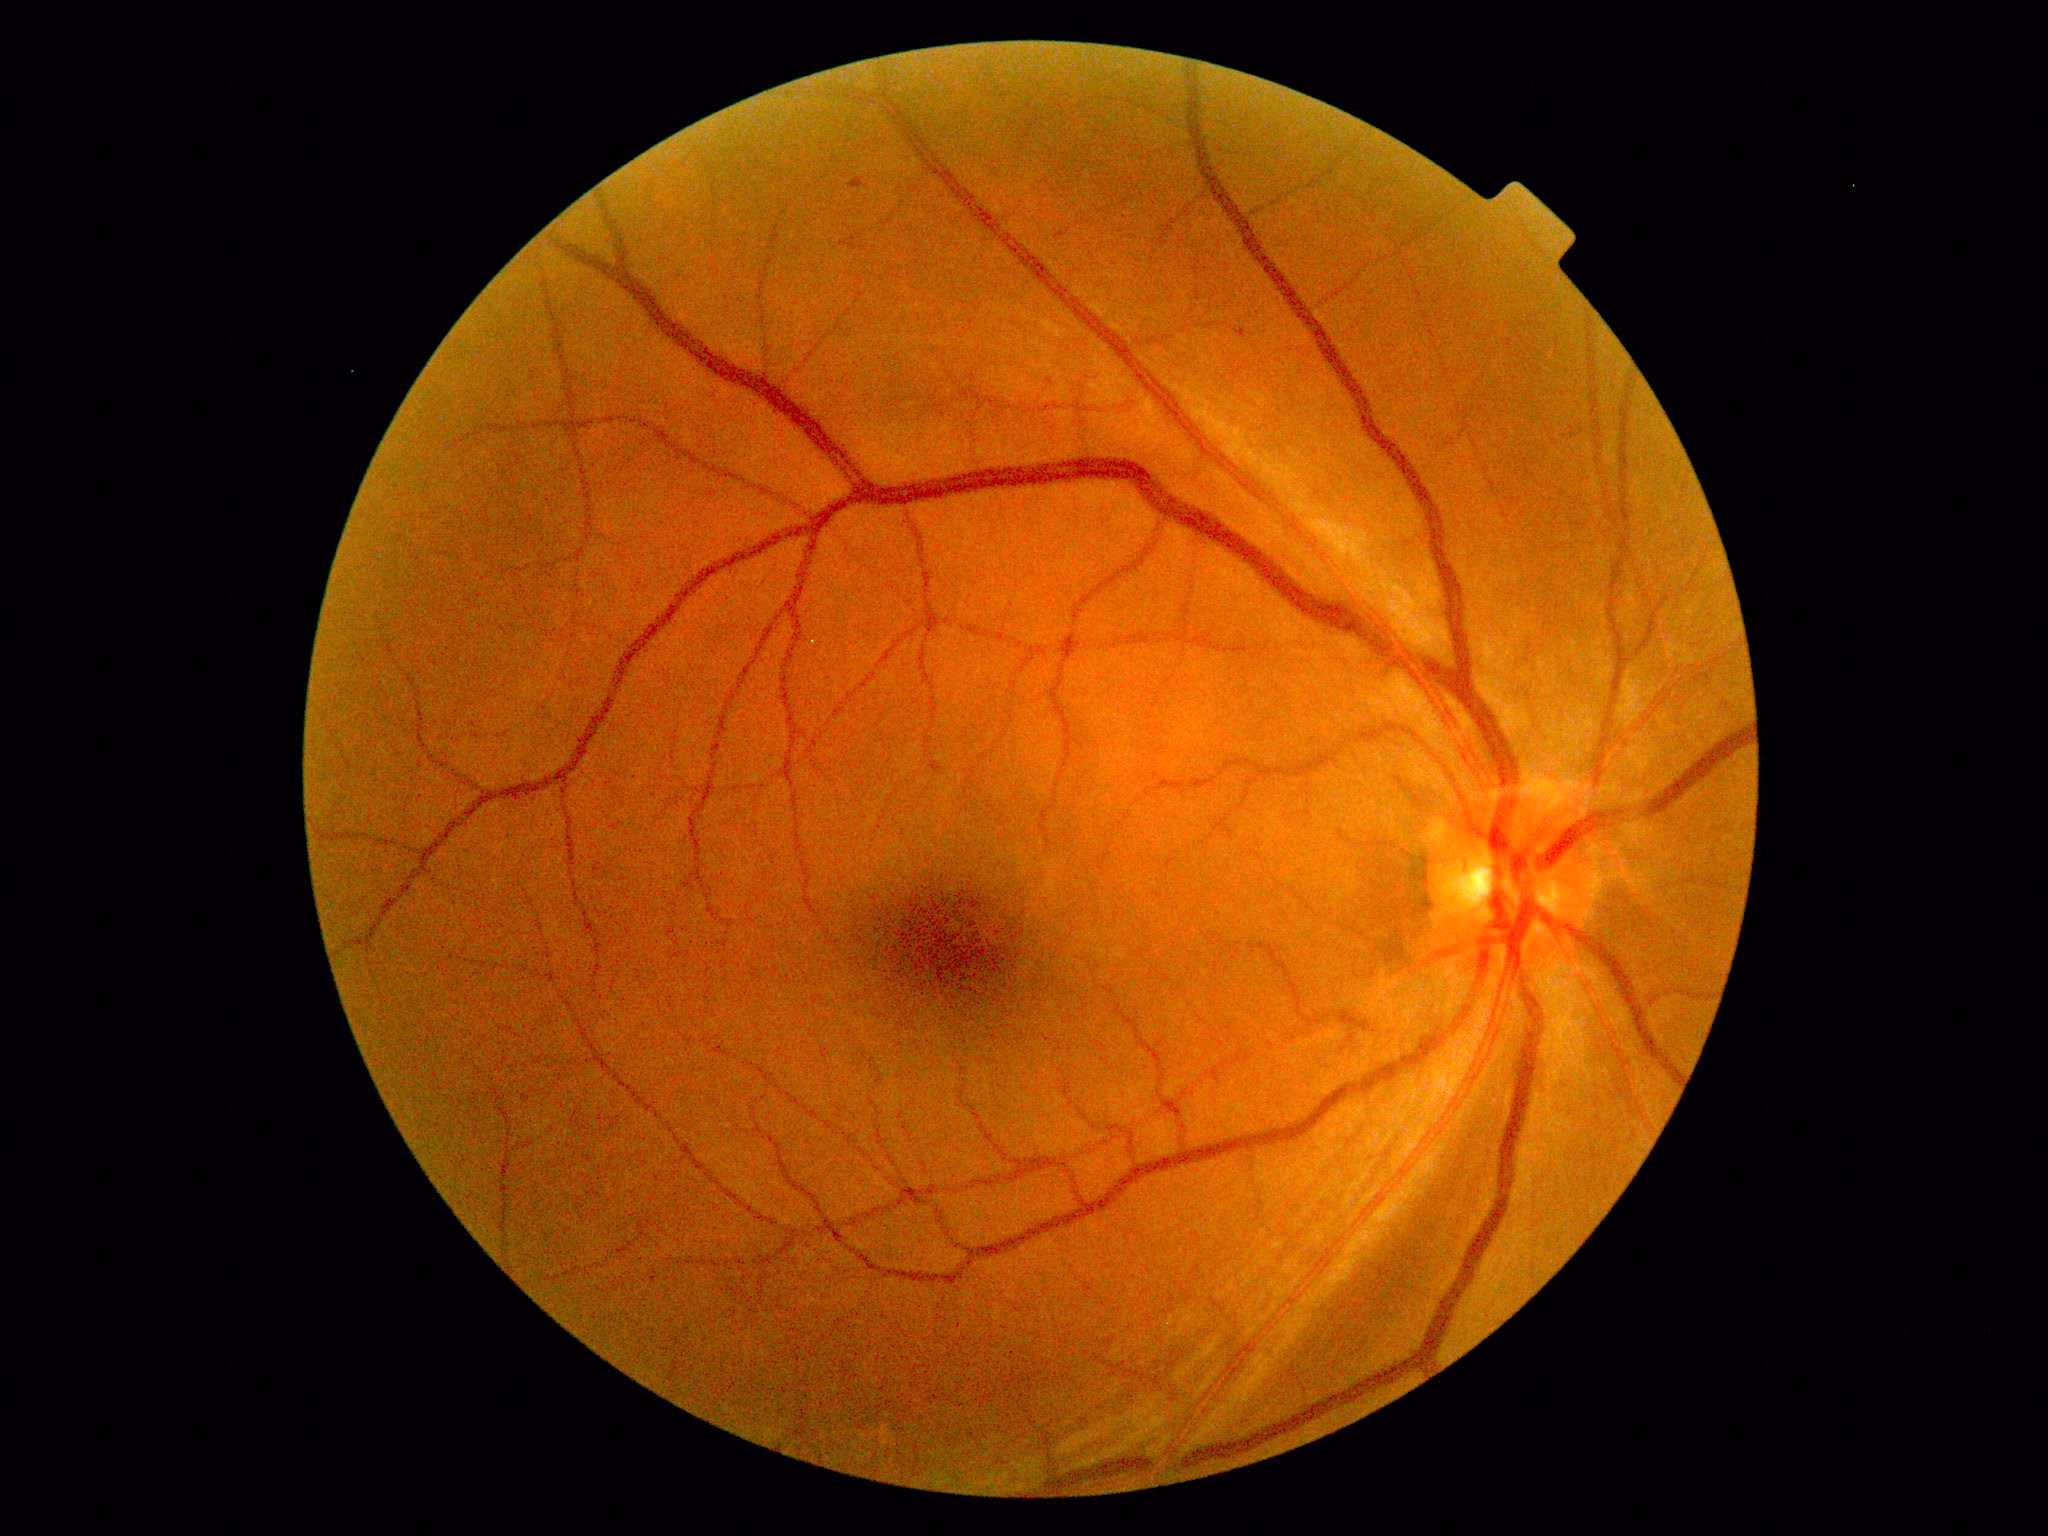 Diabetic retinopathy is 1 — presence of microaneurysms only
soft exudates: none identified
microaneurysms: <bbox>930, 762, 944, 774</bbox> | <bbox>1504, 340, 1514, 347</bbox> | <bbox>849, 178, 864, 189</bbox> | <bbox>1235, 327, 1248, 339</bbox>
Small microaneurysms approximately at [632, 462]
hemorrhages: none identified
hard exudates: none identified